Infant wide-field fundus photograph; Phoenix ICON, 100° FOV: 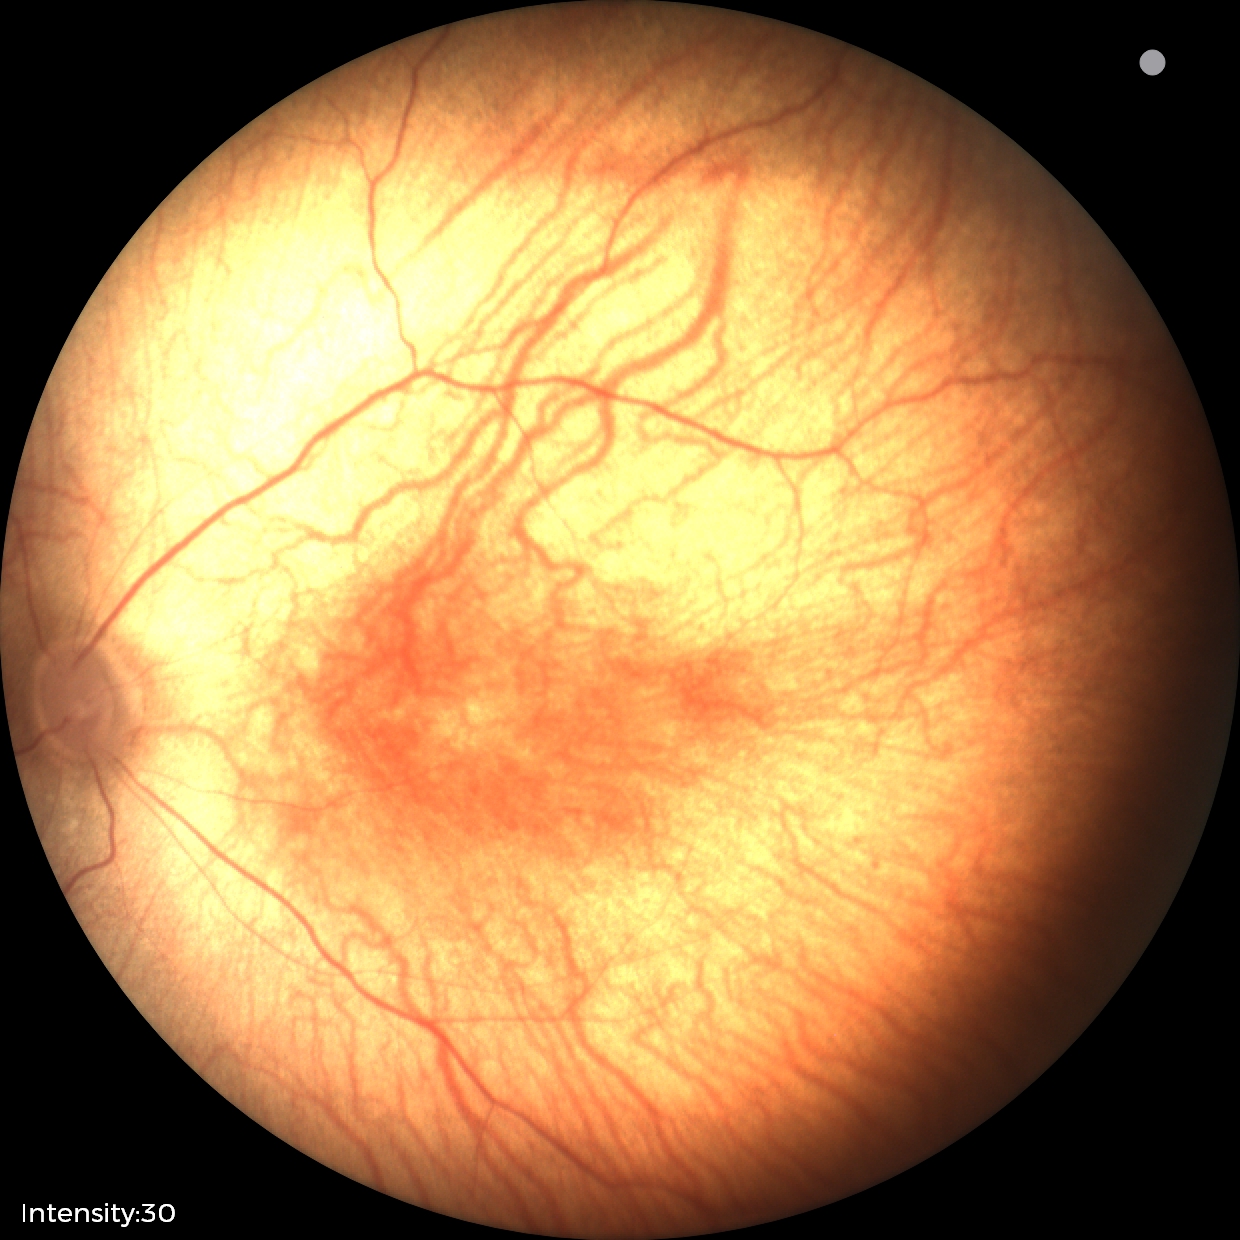
No retinal pathology identified on screening.